45 degree fundus photograph — 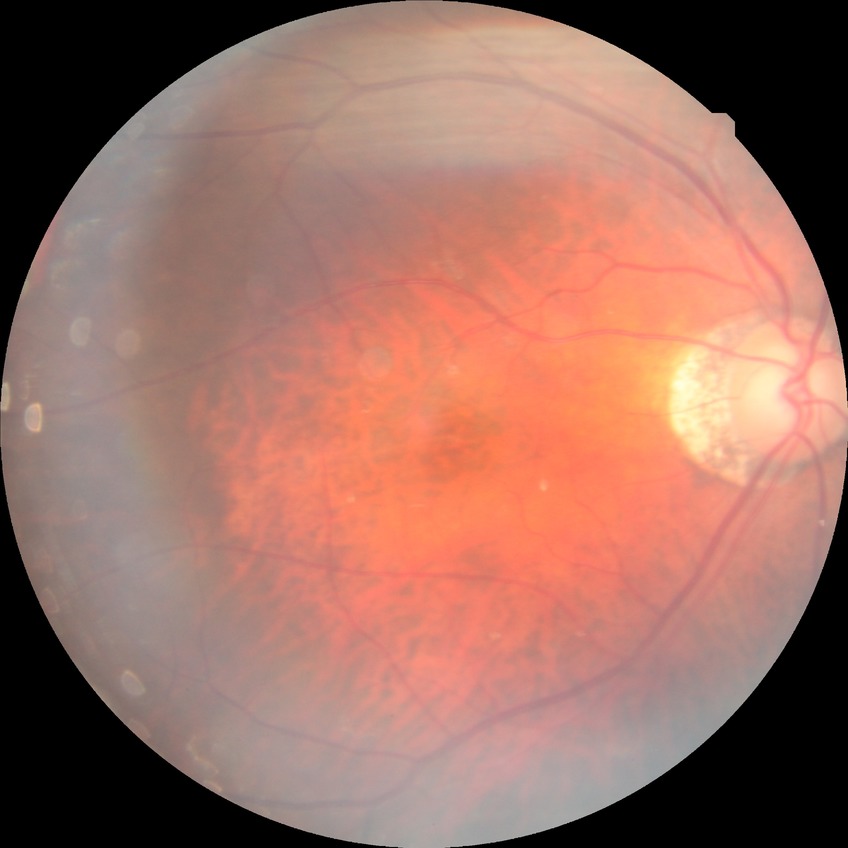
diabetic retinopathy (DR) = NDR (no diabetic retinopathy)